DR severity per modified Davis staging — 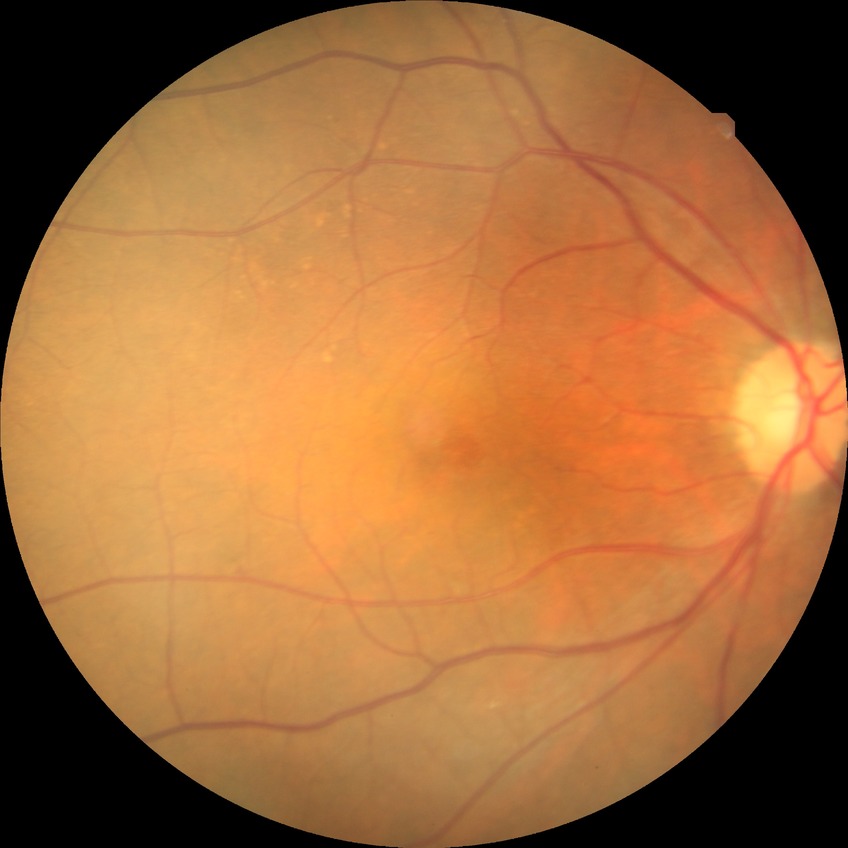

Diabetic retinopathy (DR): no diabetic retinopathy (NDR).